Infant wide-field fundus photograph; acquired on the Natus RetCam Envision; 1440x1080: 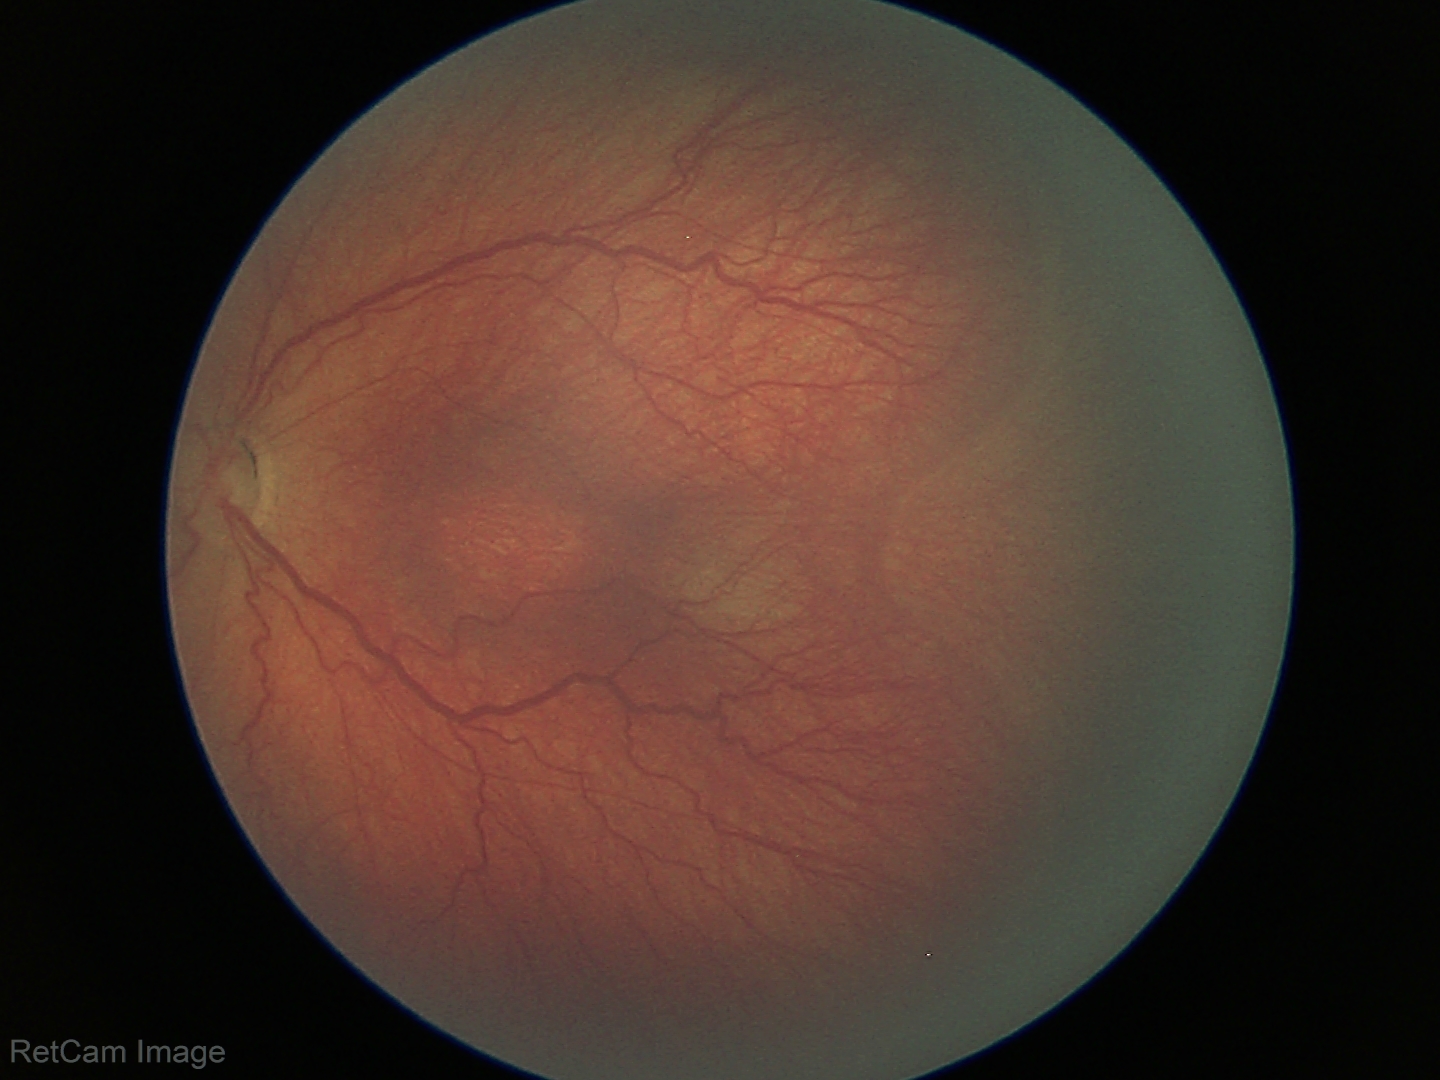

ROP grade = stage 3